Ultra-widefield fundus photograph:
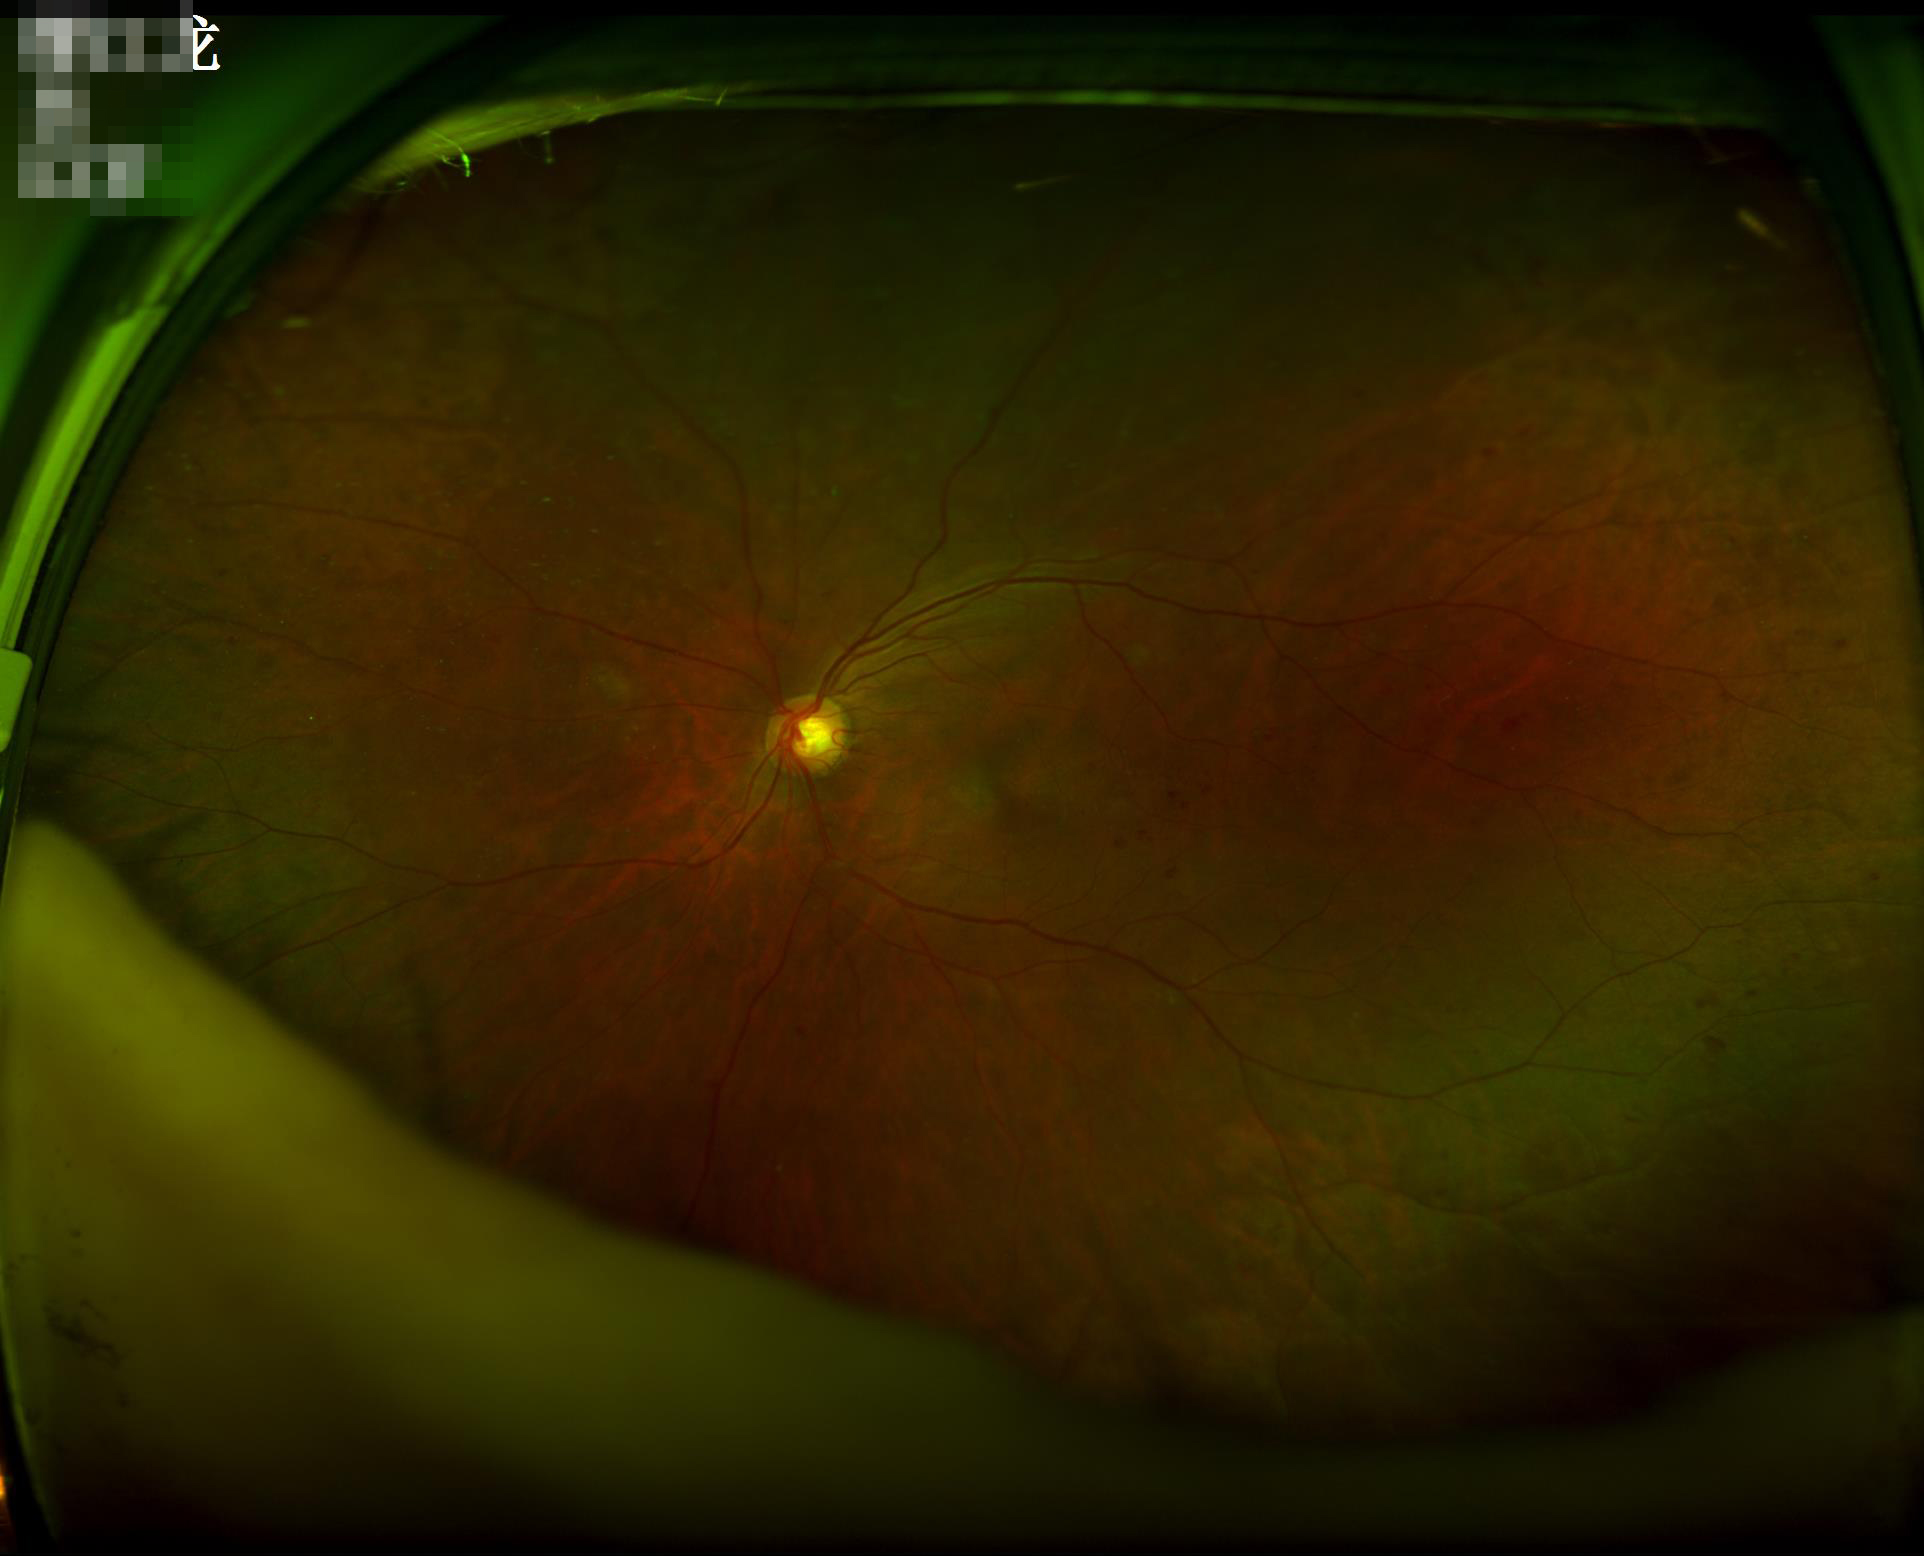
Image quality:
- illumination/color: no over- or under-exposure
- focus: sharp throughout the field
- overall: good, gradable